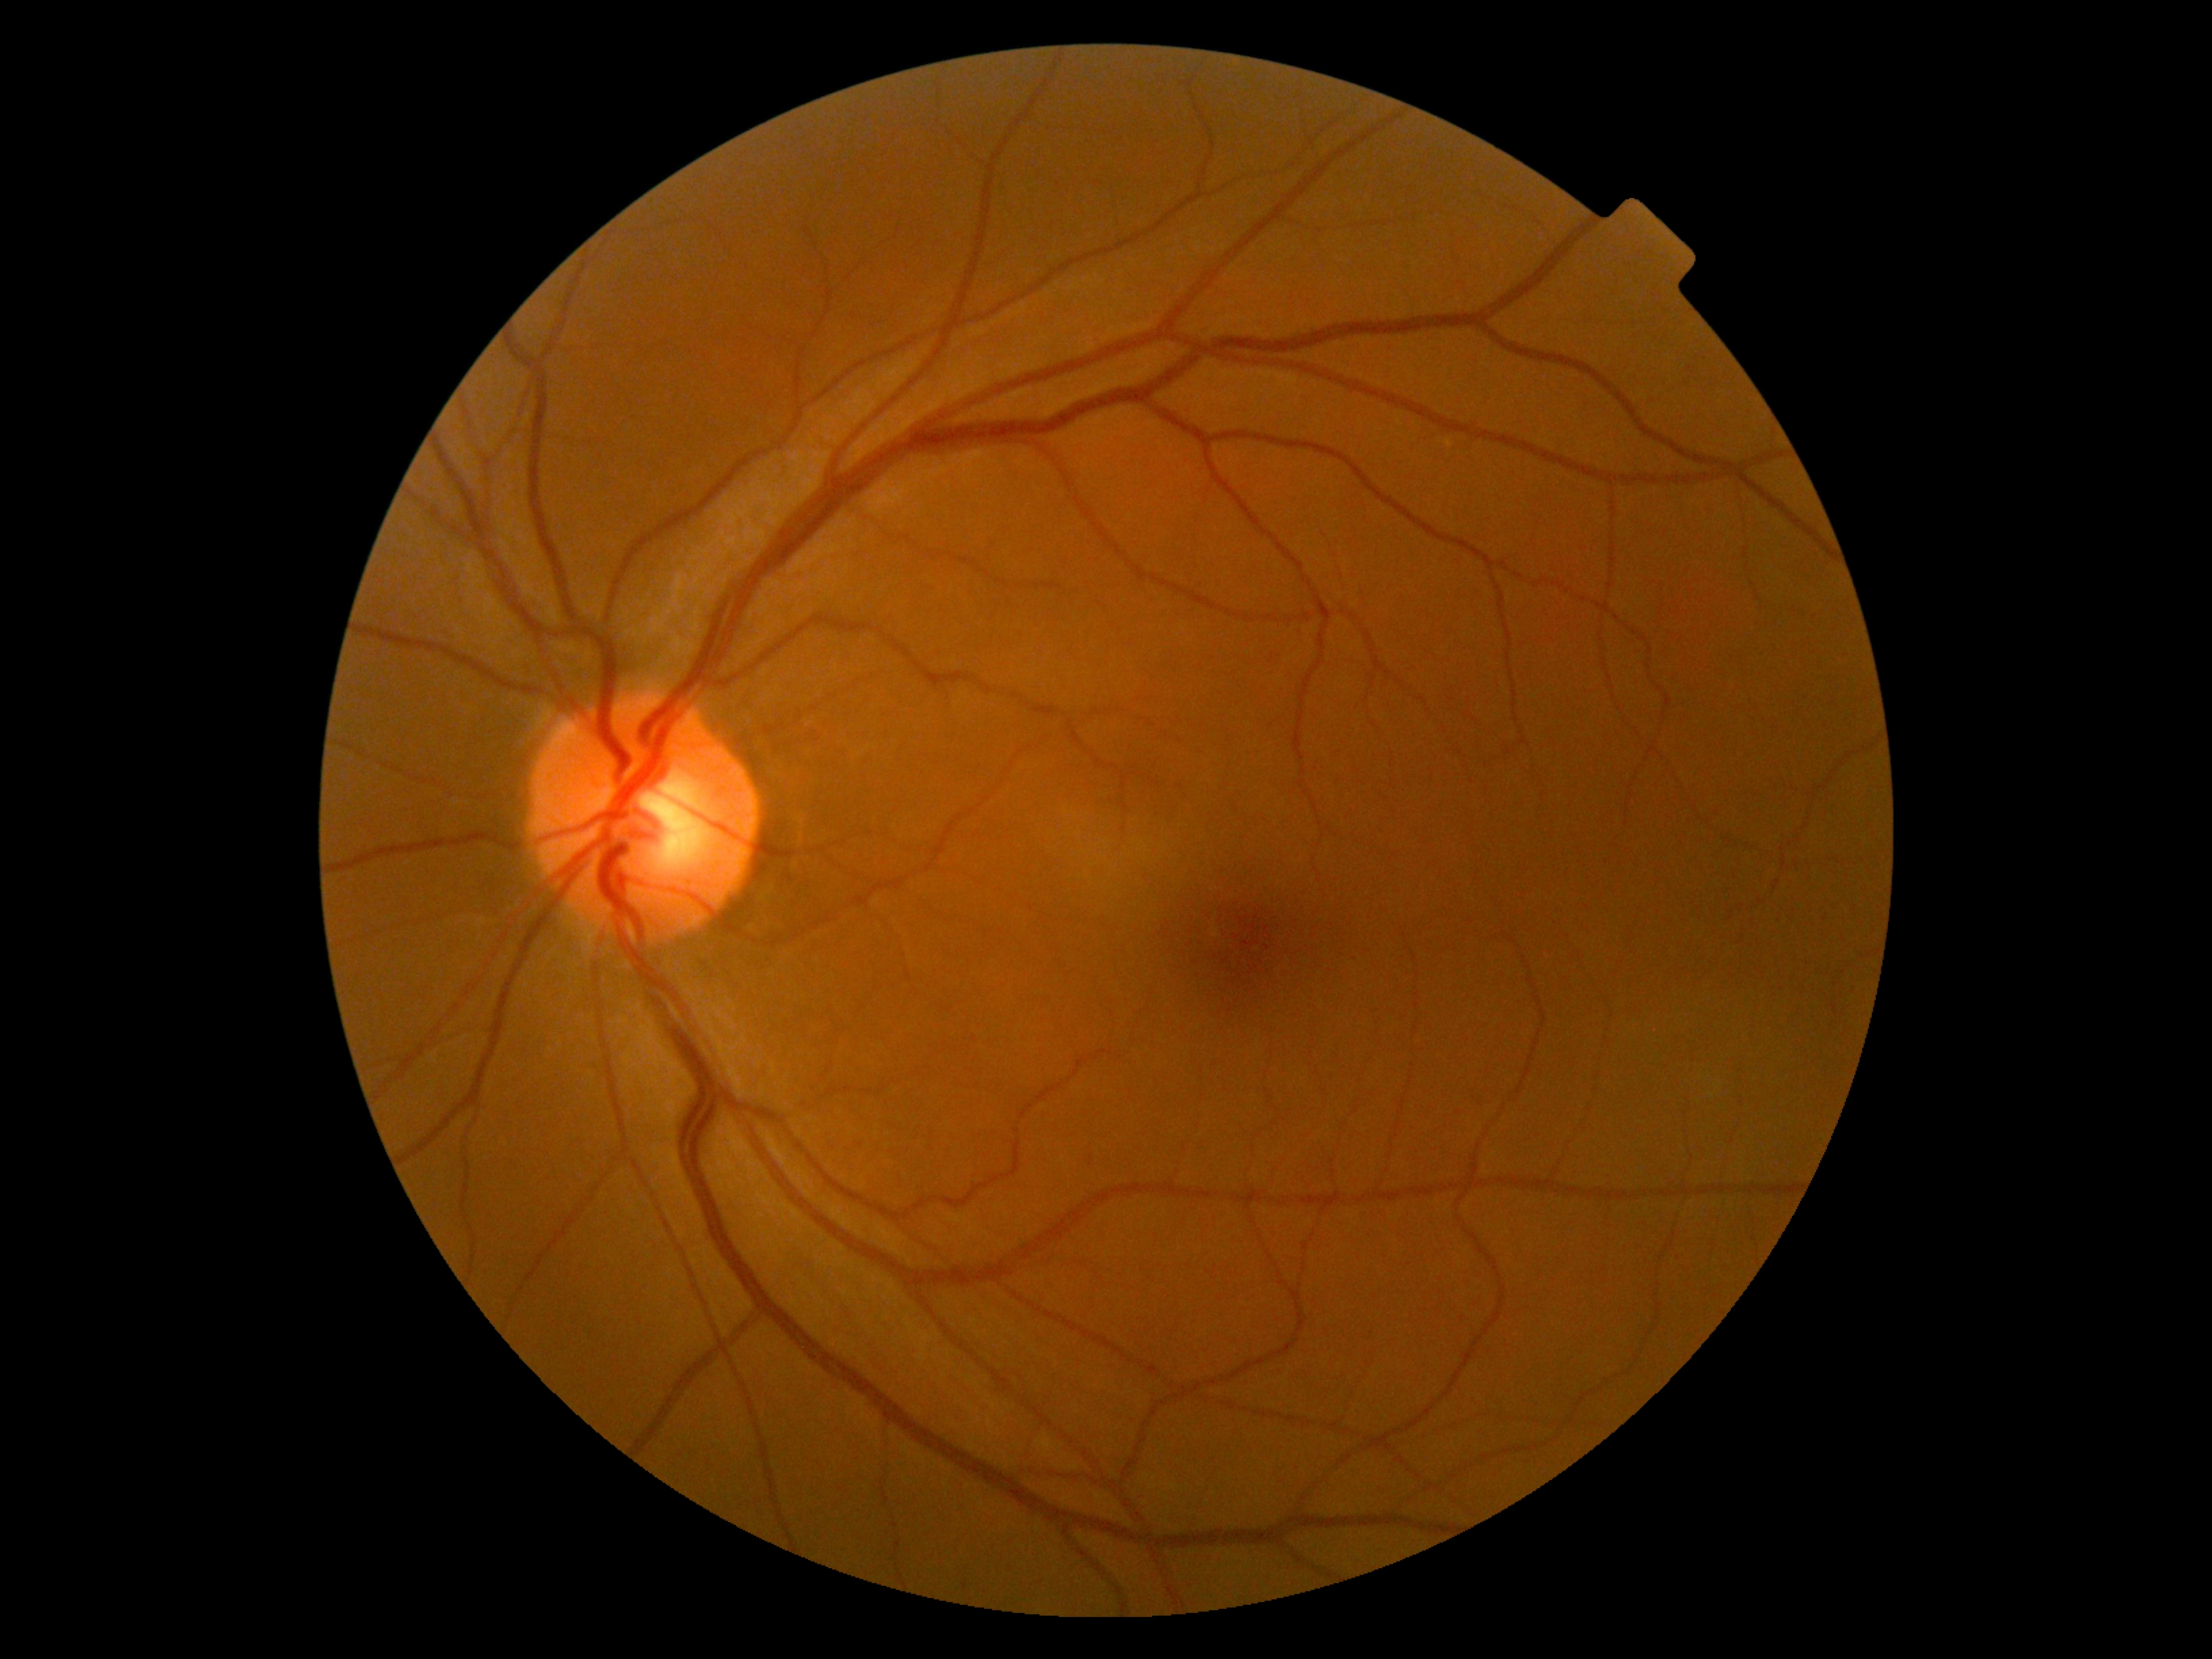

DR impression: negative for DR
DR: grade 0